RetCam wide-field infant fundus image; Clarity RetCam 3, 130° FOV.
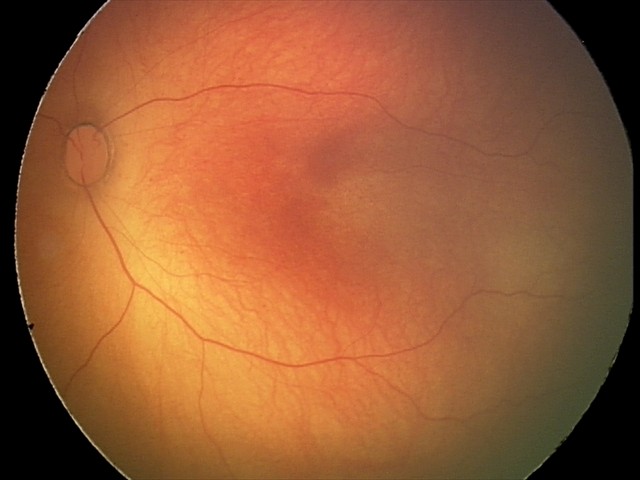

Examination with physiological retinal findings.